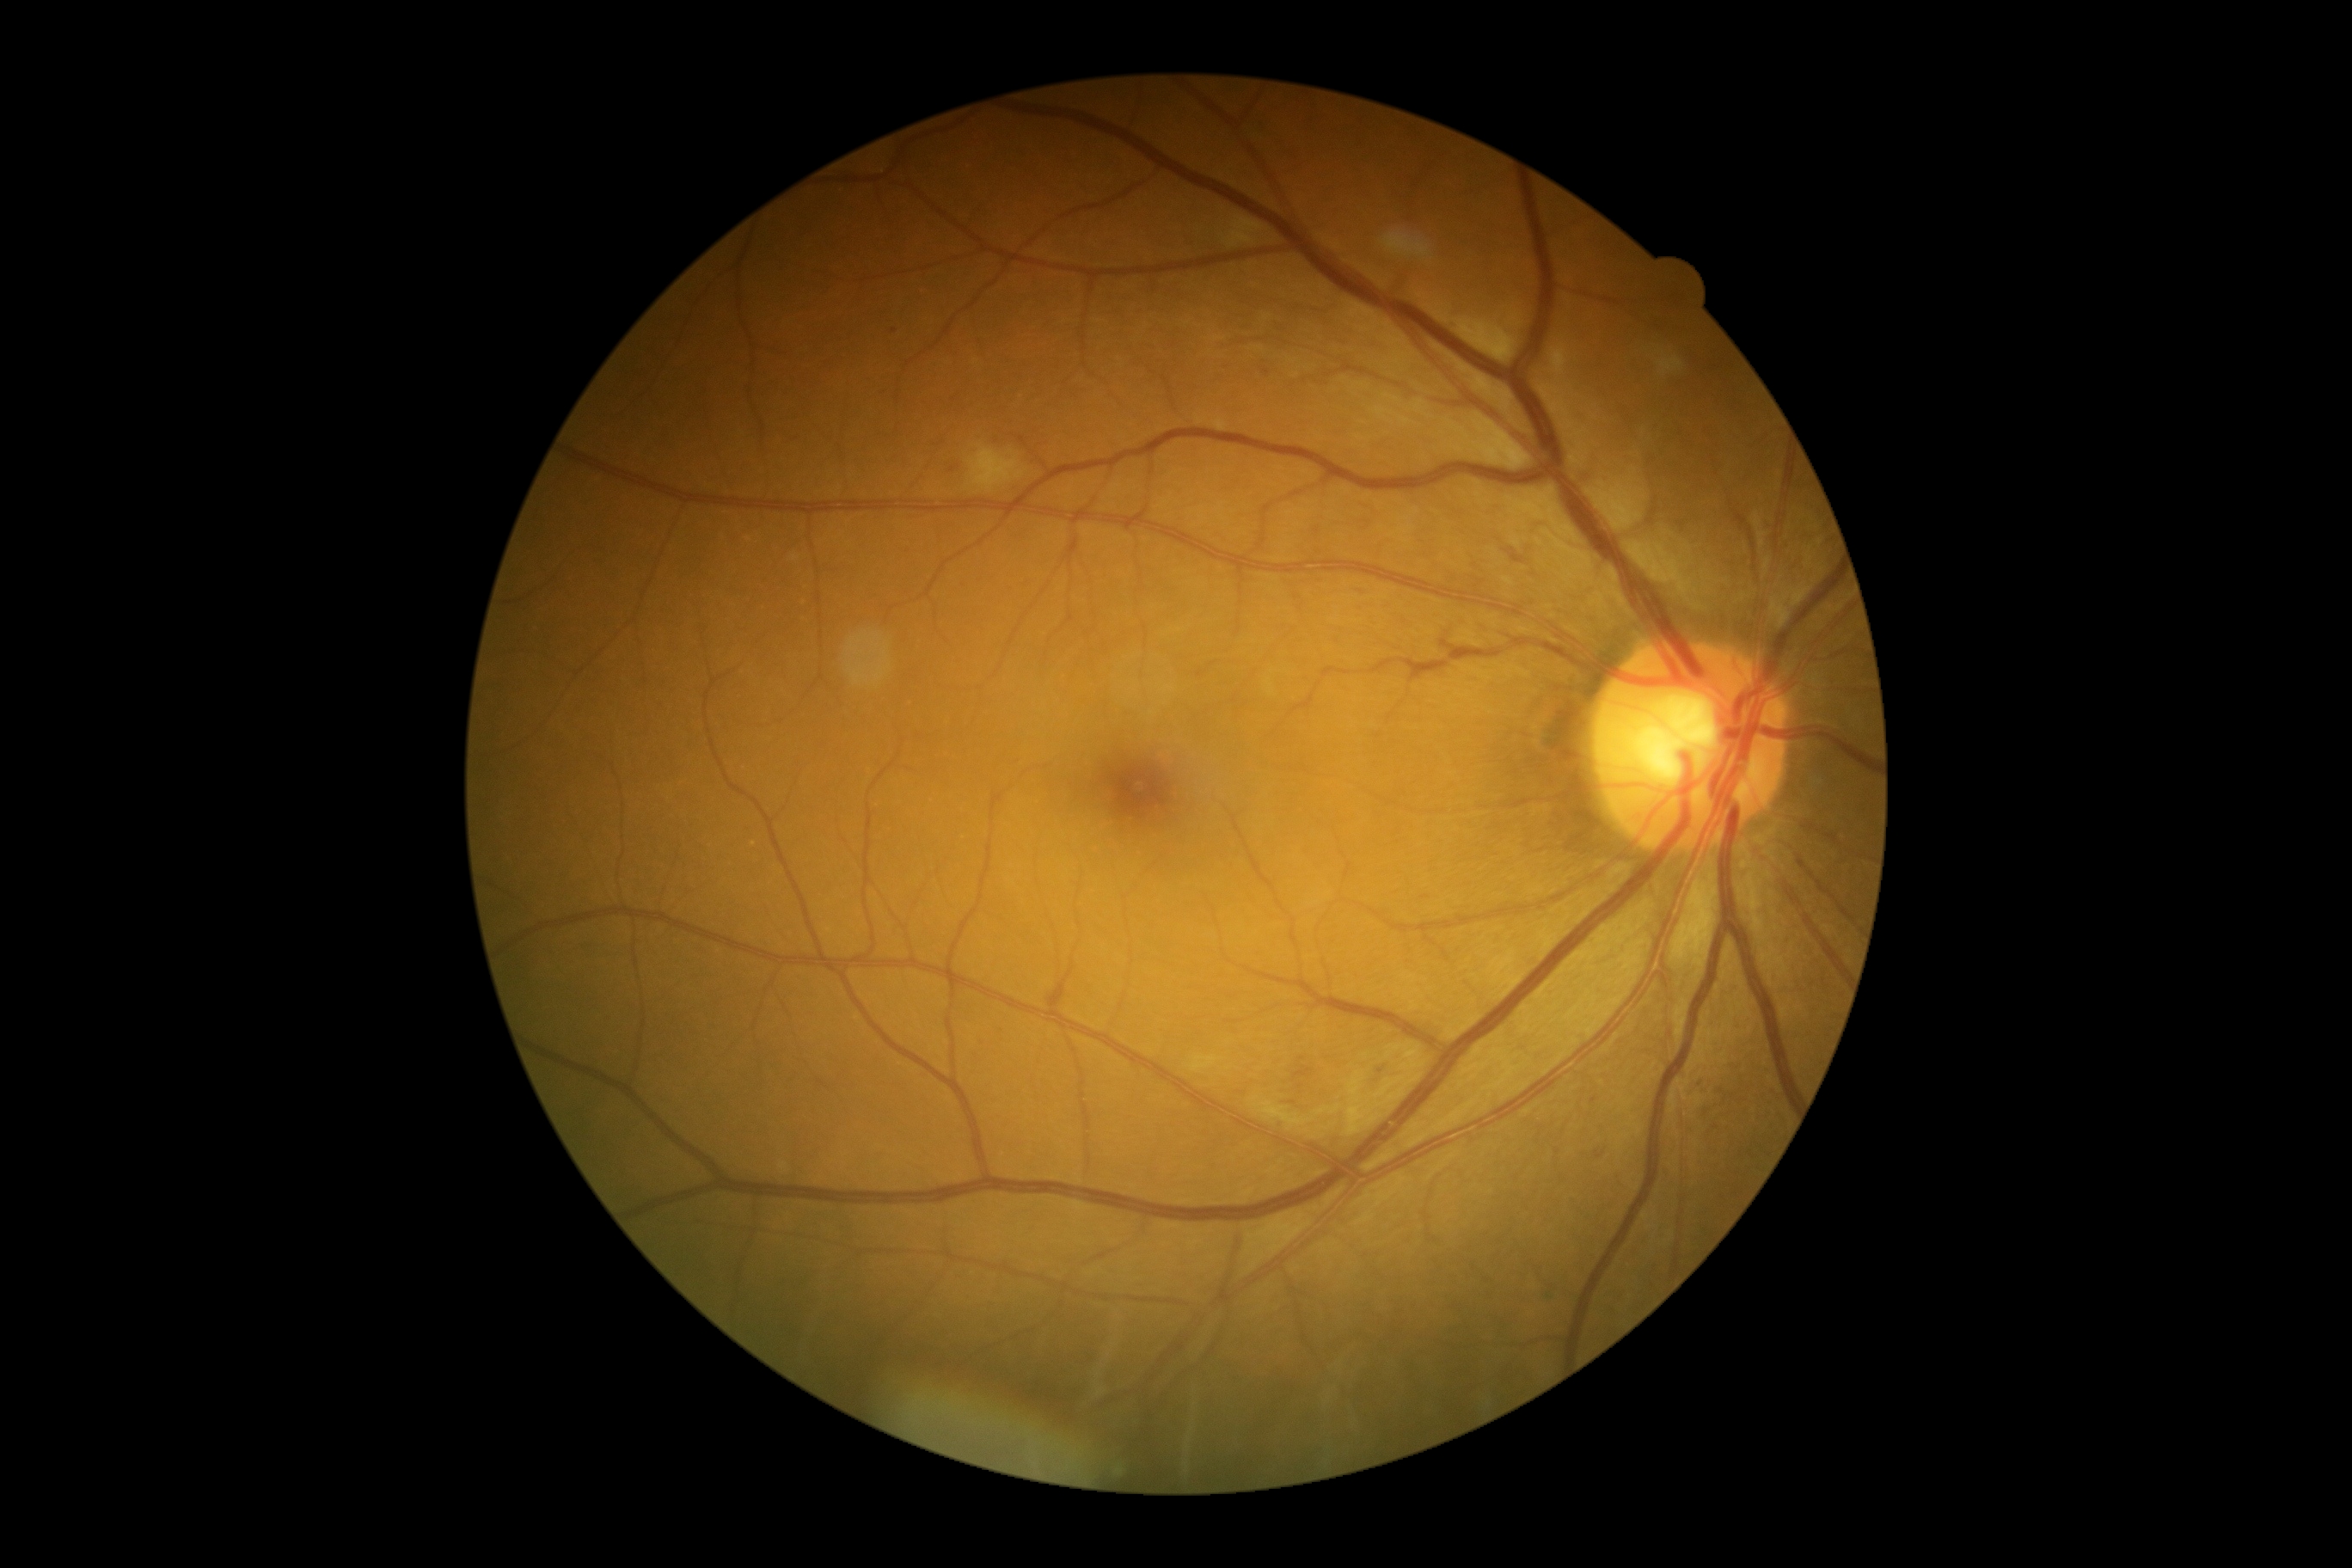 Diabetic retinopathy severity is grade 2.